Image size 640x480; RetCam wide-field infant fundus image: 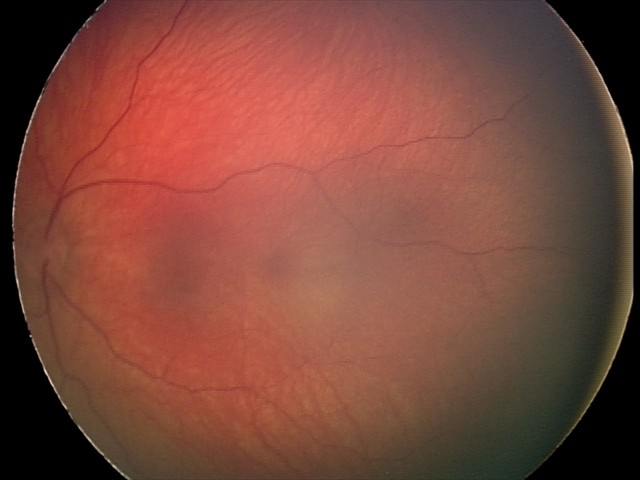

Examination diagnosed as retinal hemorrhages.